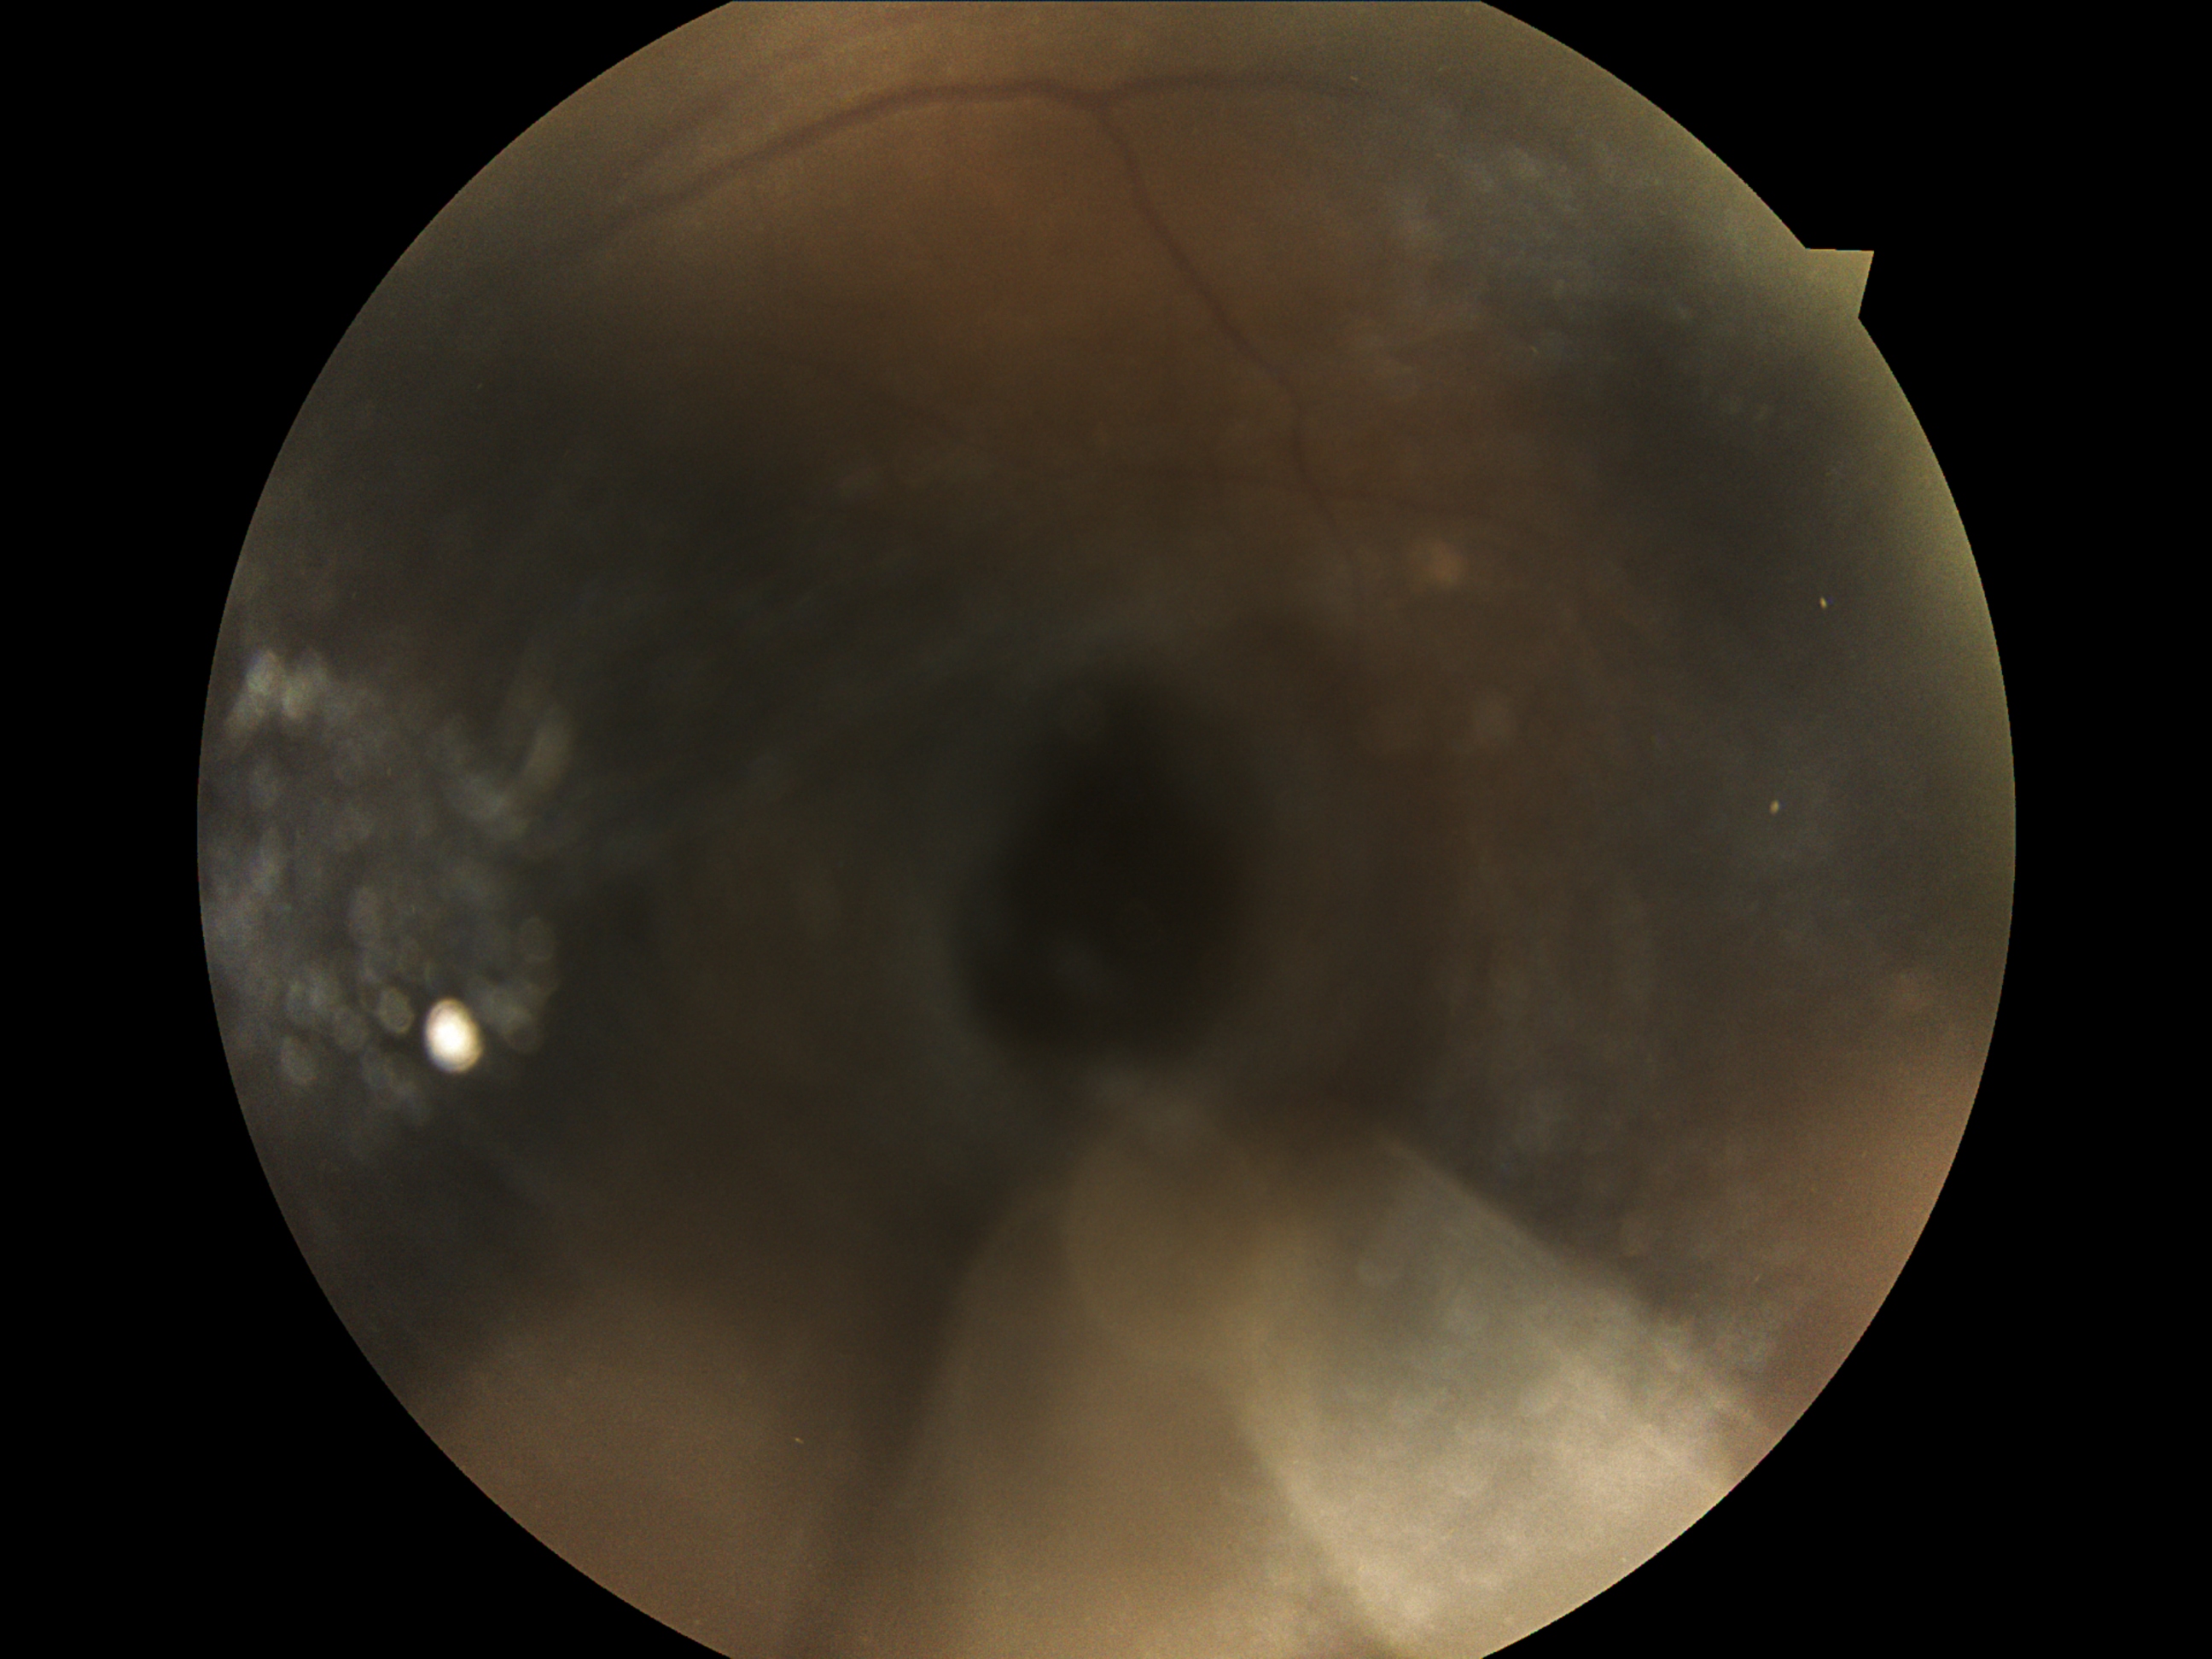

image quality: too poor for DR grading; DR grade: ungradable due to poor image quality.